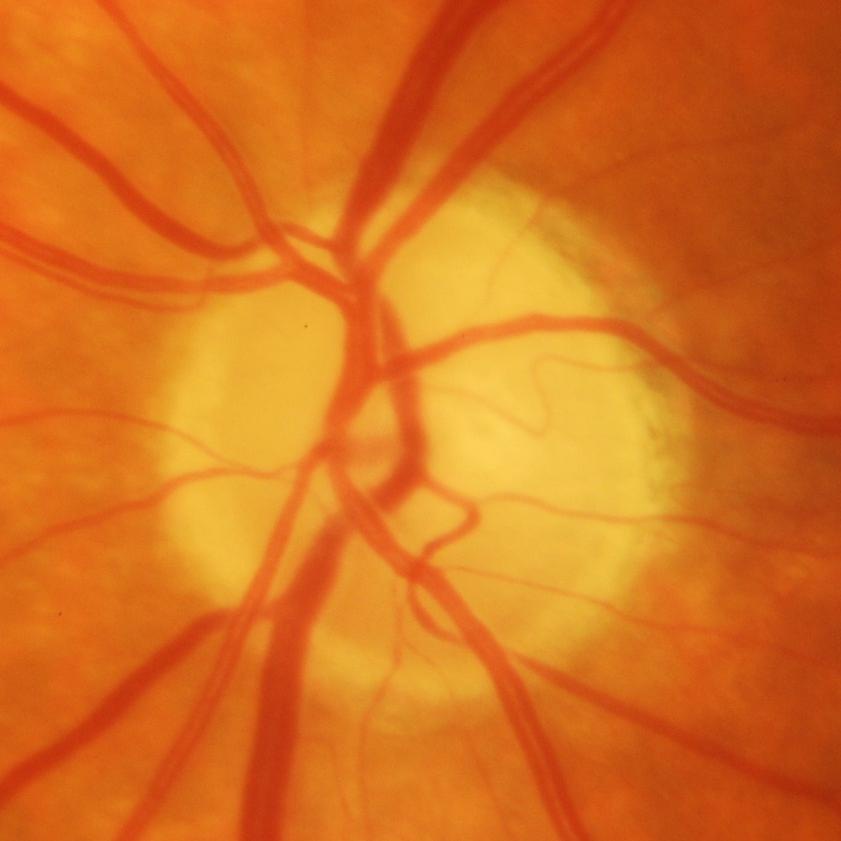
Q: Glaucoma assessment?
A: Glaucomatous damage to the optic nerve.